FOV: 45 degrees. 2352x1568px. CFP:
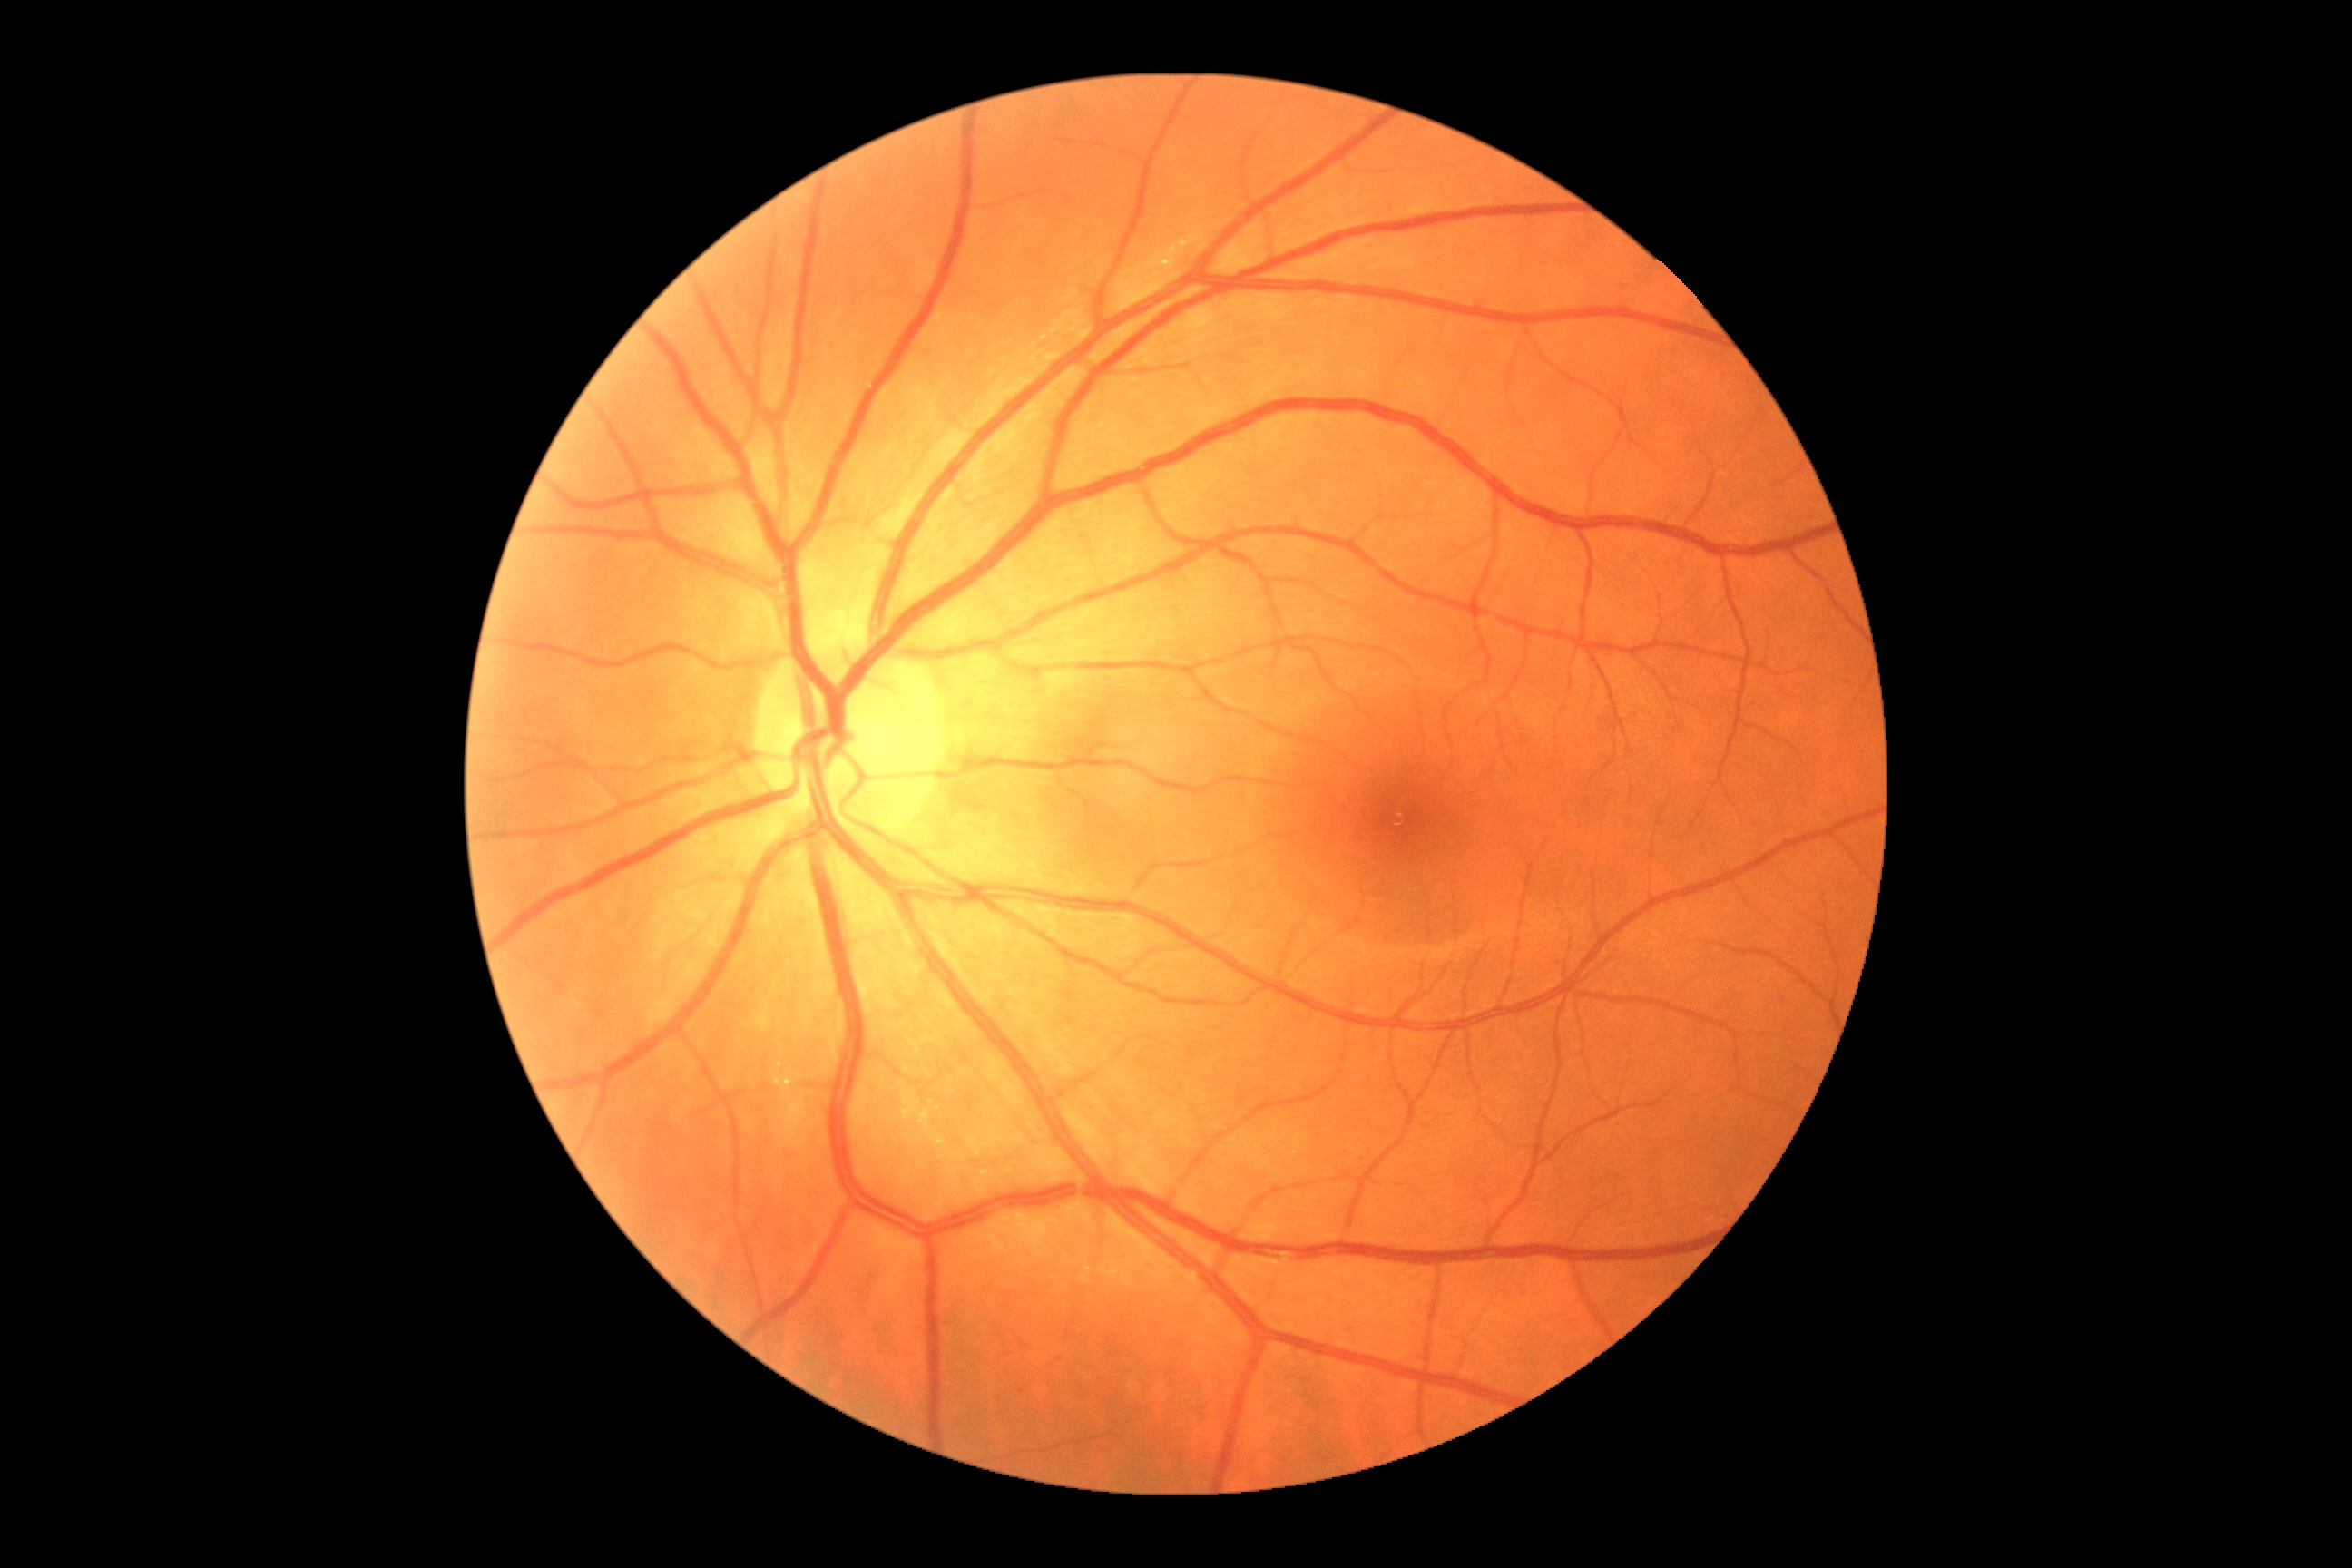

Diabetic retinopathy (DR) is 0/4.
No signs of diabetic retinopathy.